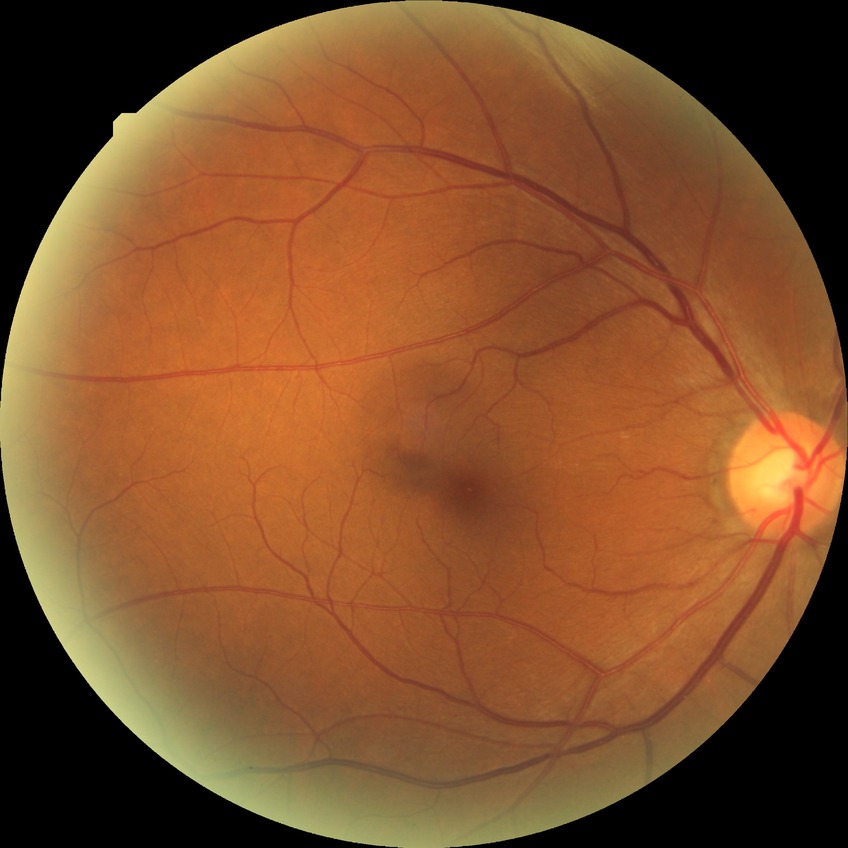 davis_grade: NDR (no diabetic retinopathy)